FOV: 200 degrees: 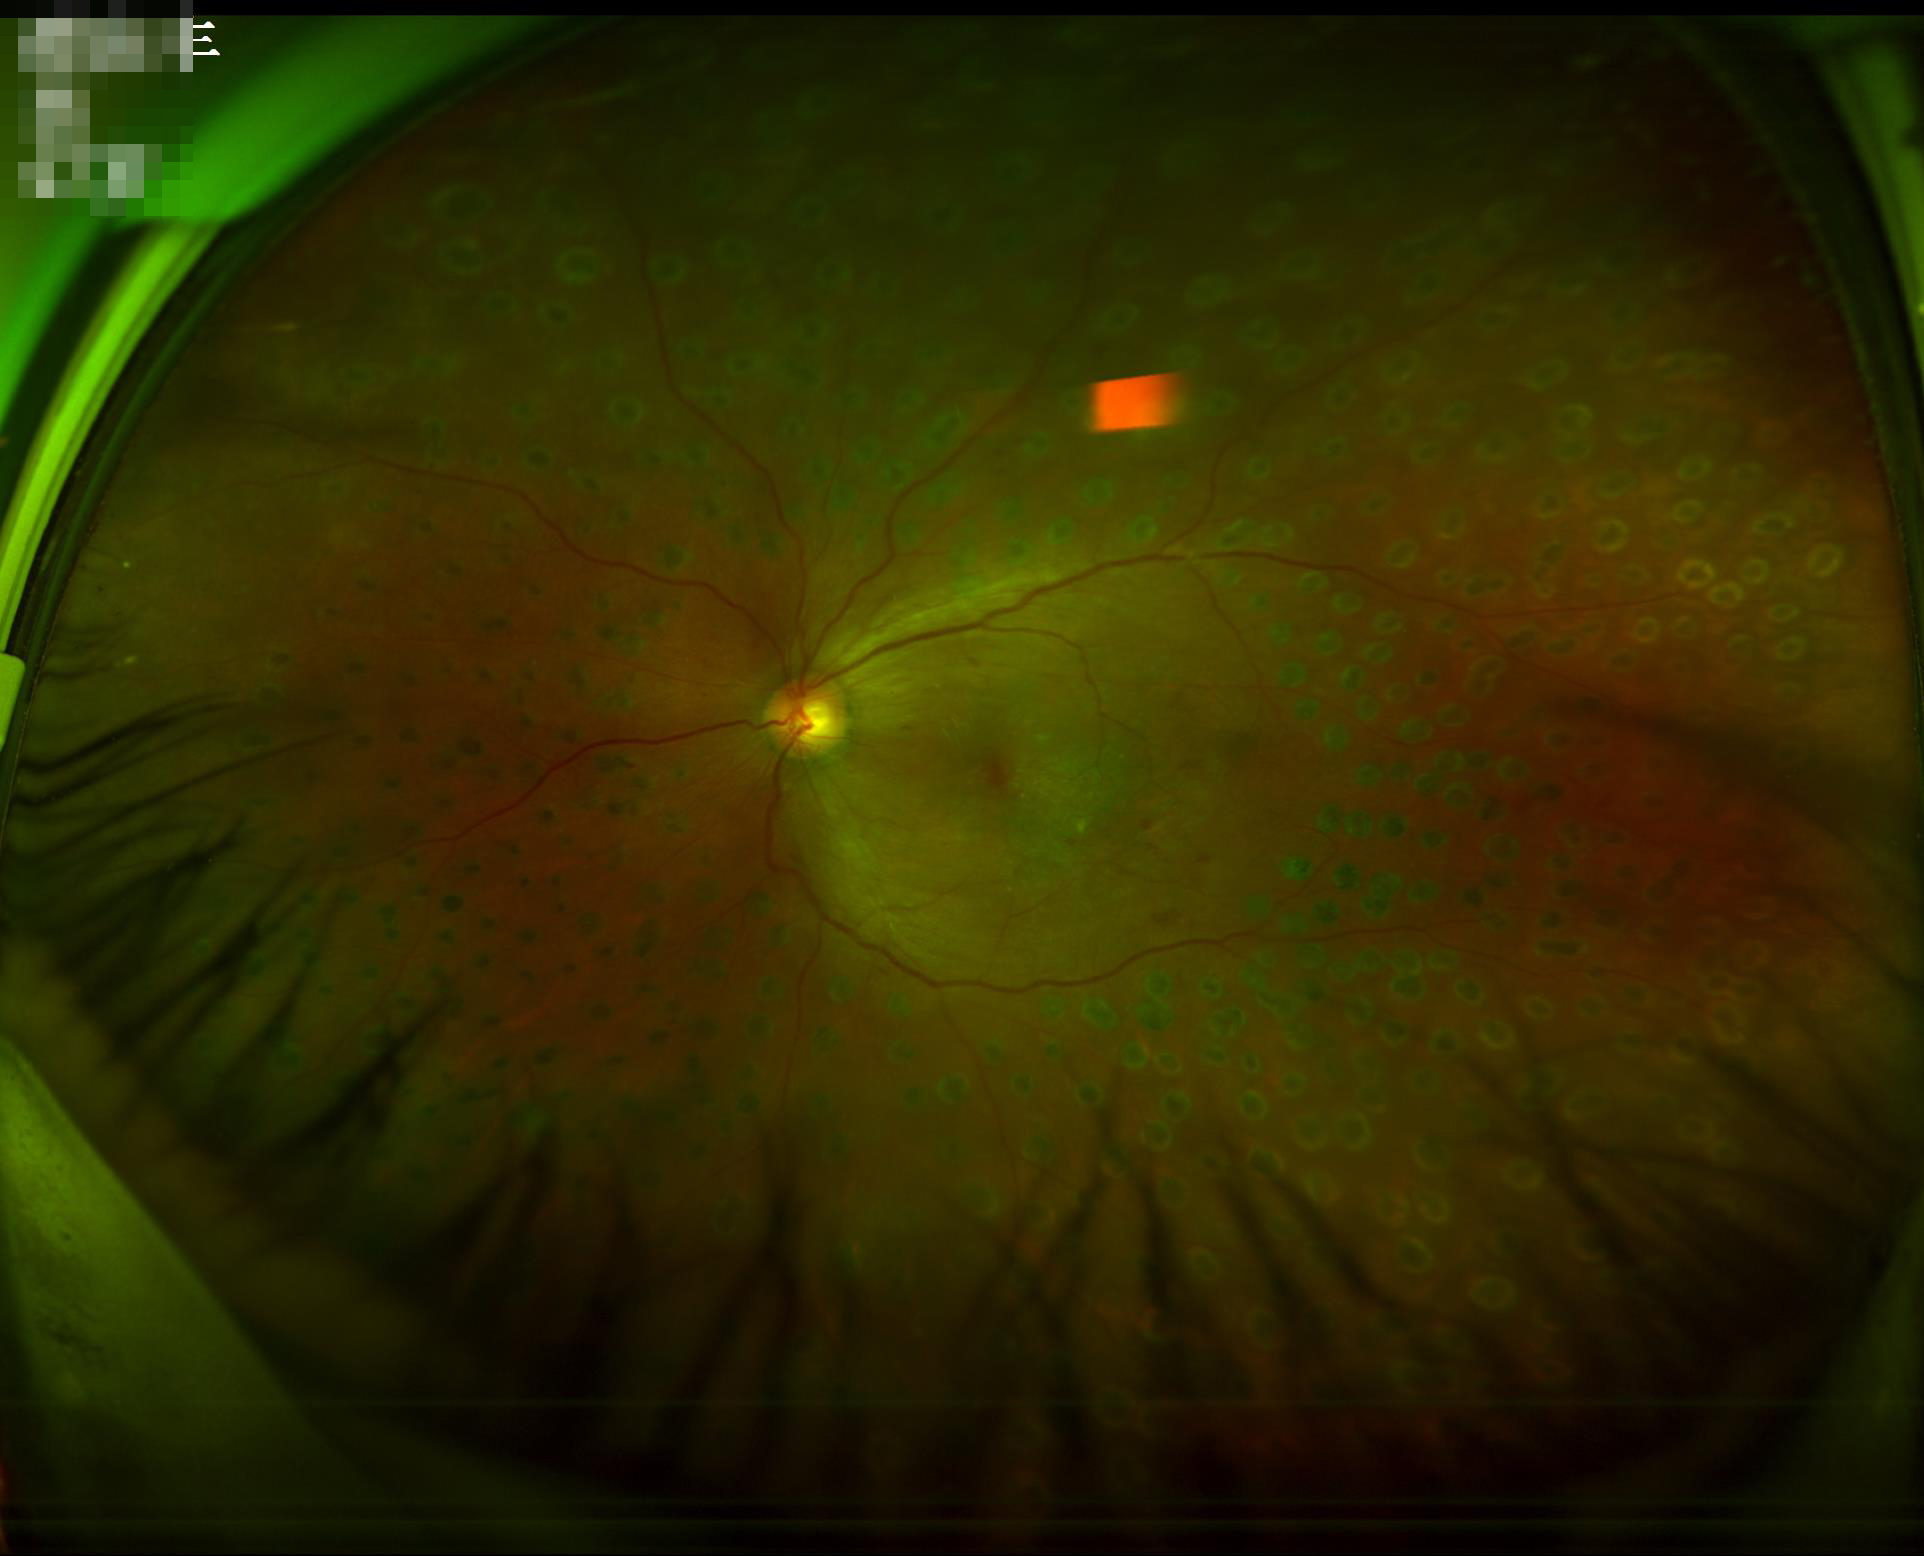
{"contrast": "adequate", "overall_quality": "adequate", "illumination": "uneven"}